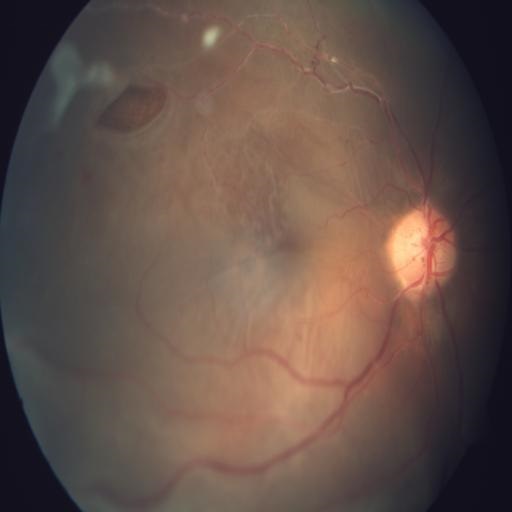
Showing RHL (retinal hole) & RD (retinal detachment).